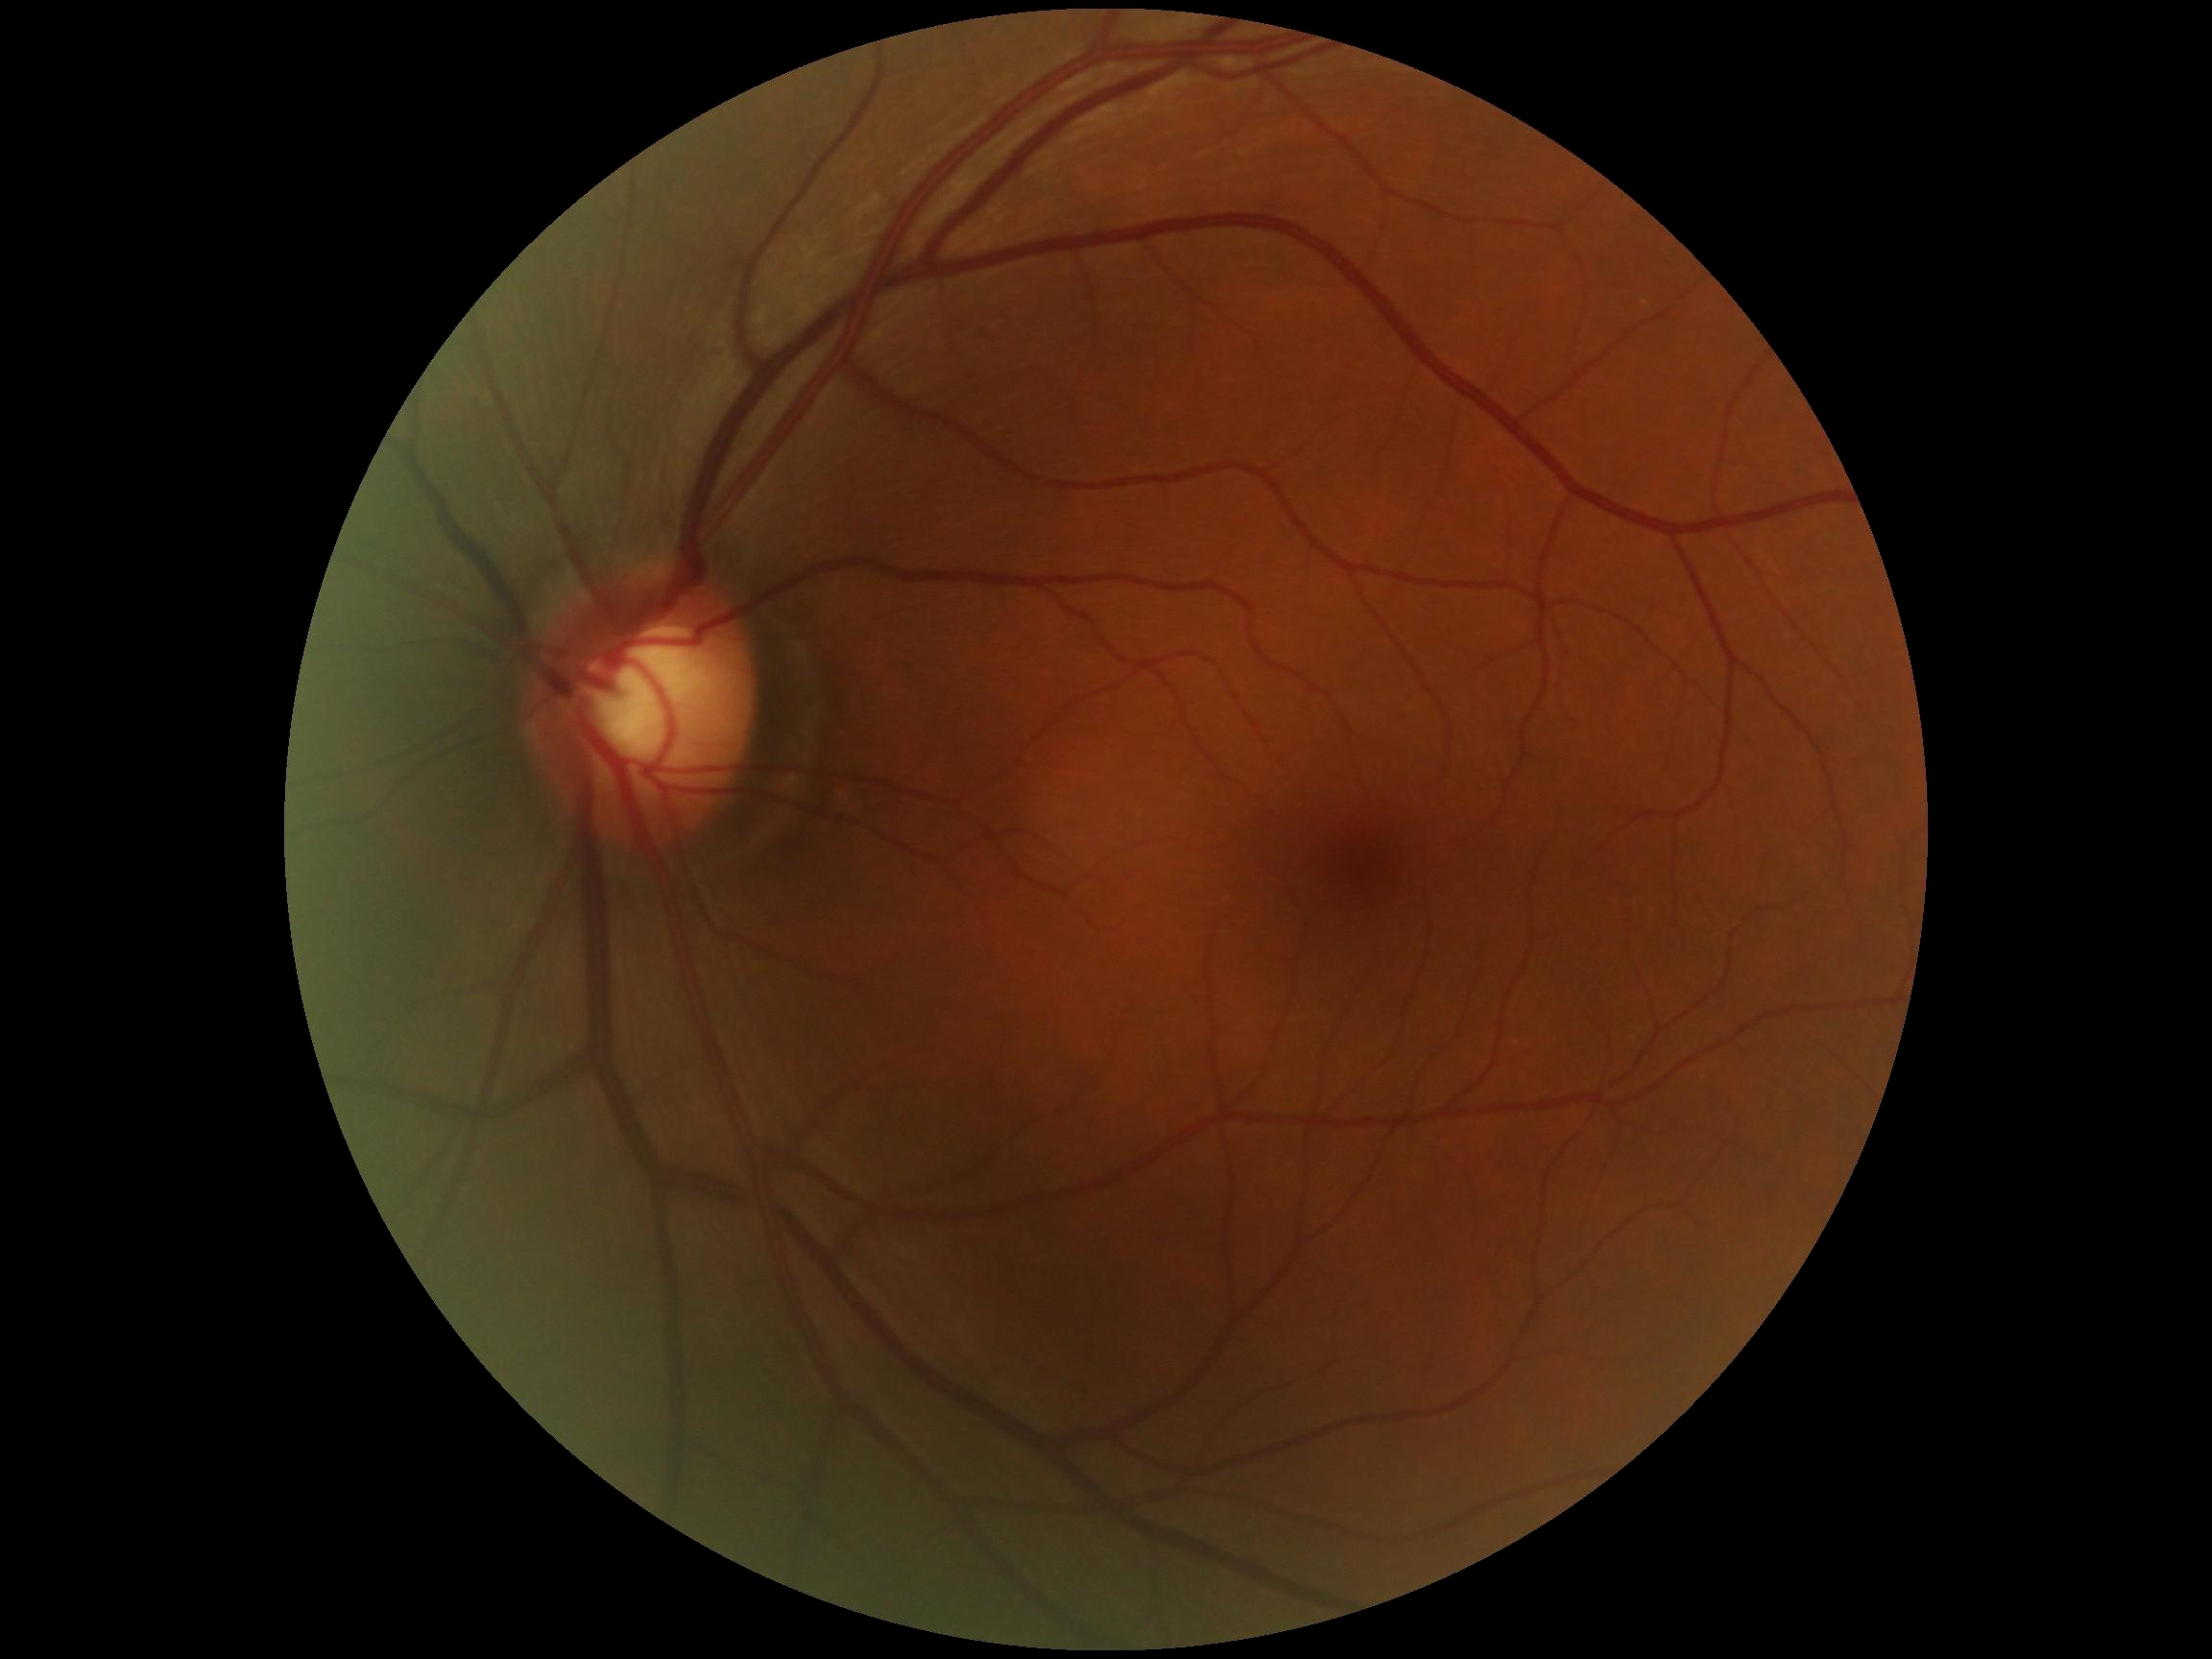
DR: grade 0 (no apparent retinopathy). No diabetic retinal disease findings.